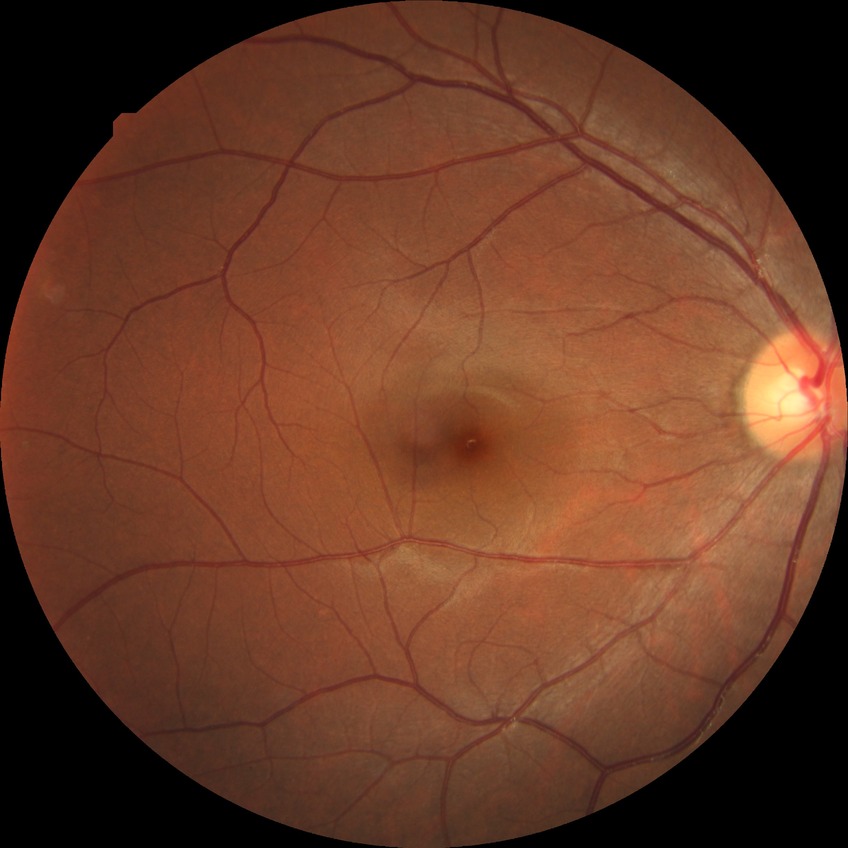

diabetic retinopathy severity = no diabetic retinopathy.